45-degree field of view.
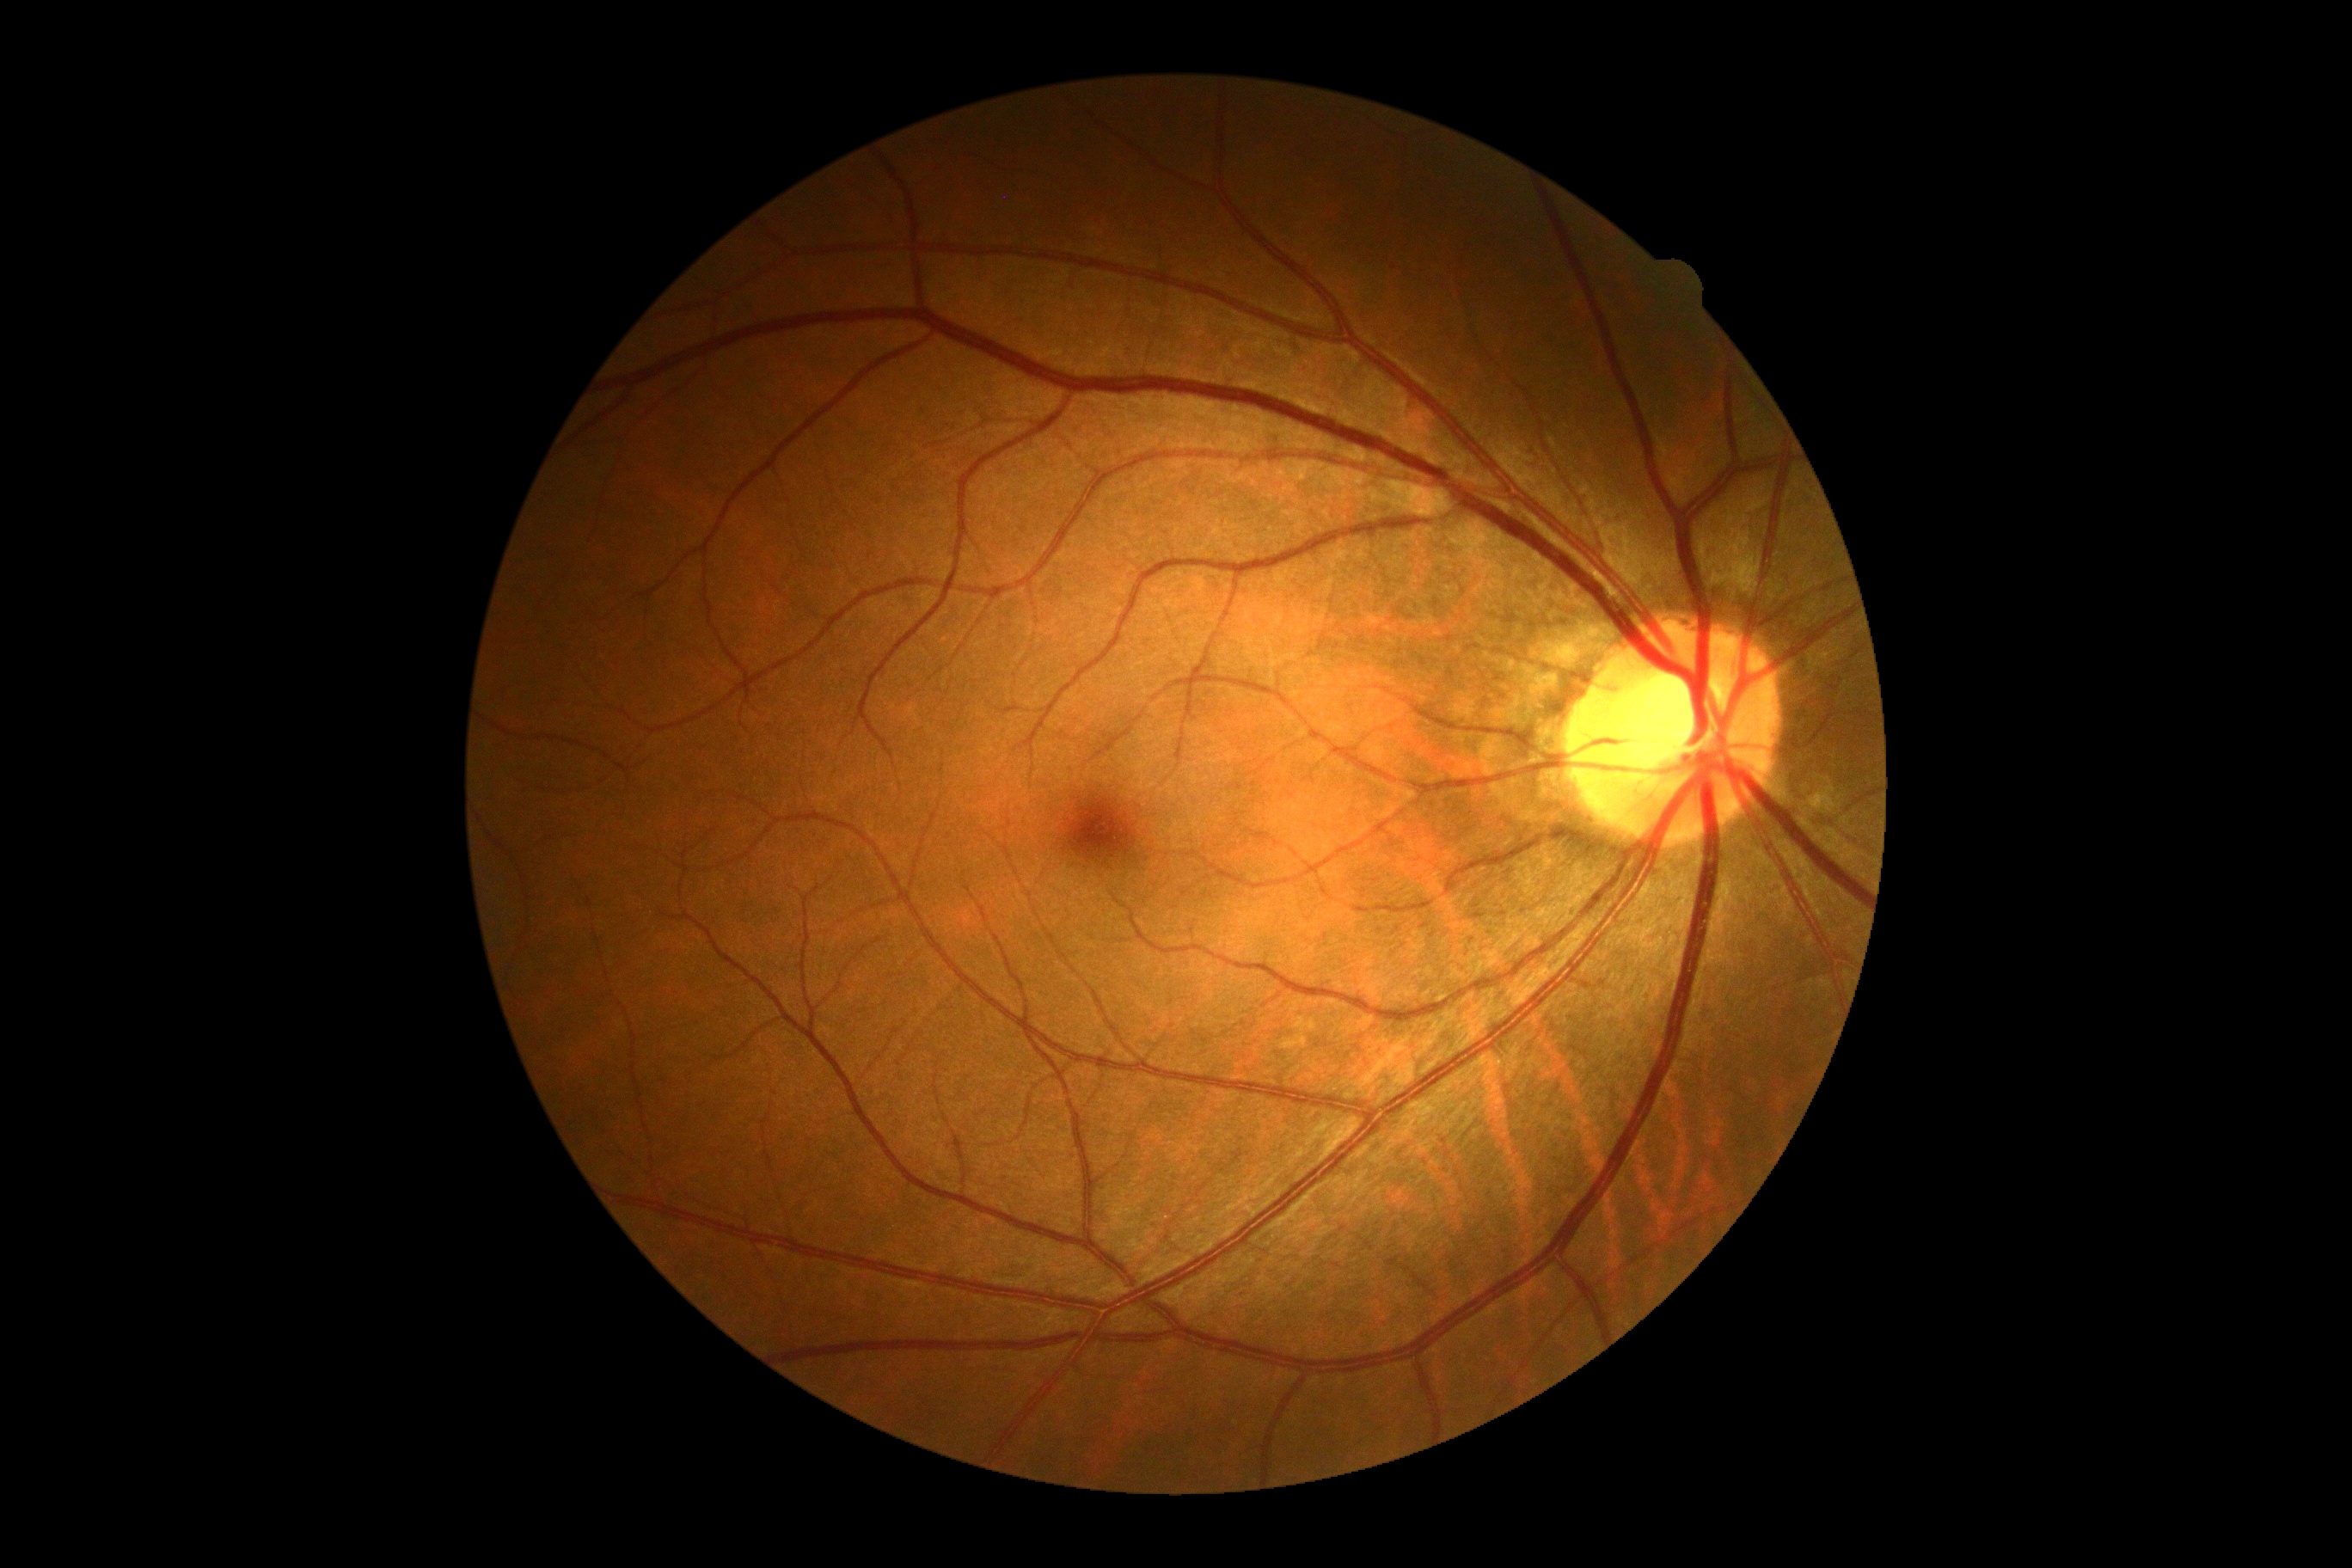

diabetic retinopathy = grade 0 (no apparent retinopathy) | DR impression = no apparent DR.